Camera: NIDEK AFC-230, Davis DR grading.
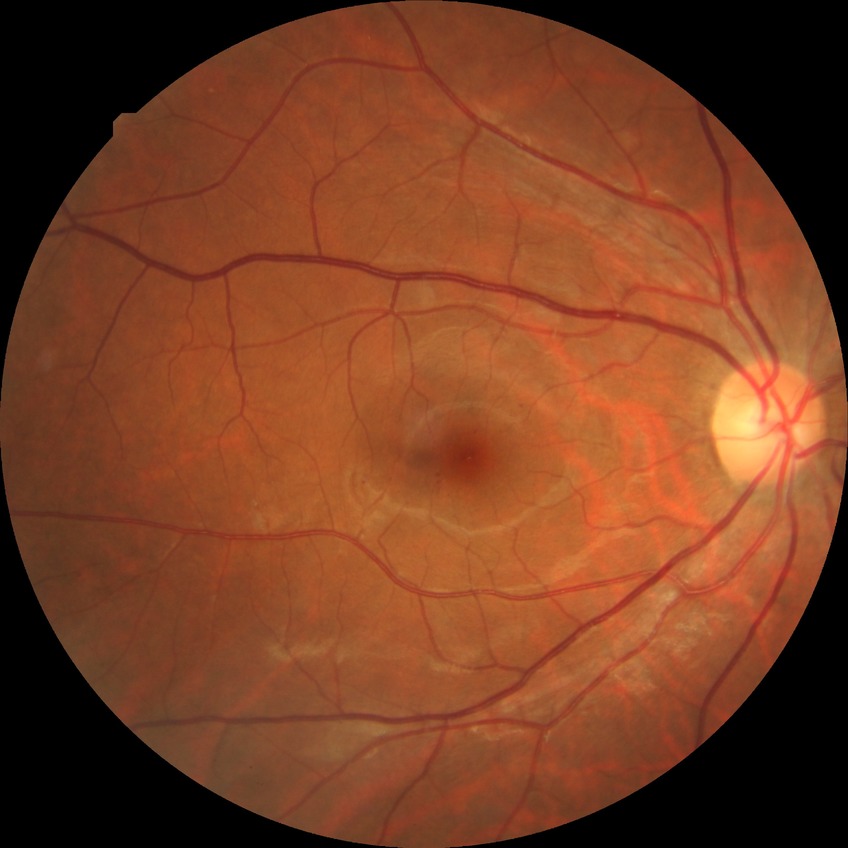
Diabetic retinopathy (DR) is simple diabetic retinopathy (SDR).